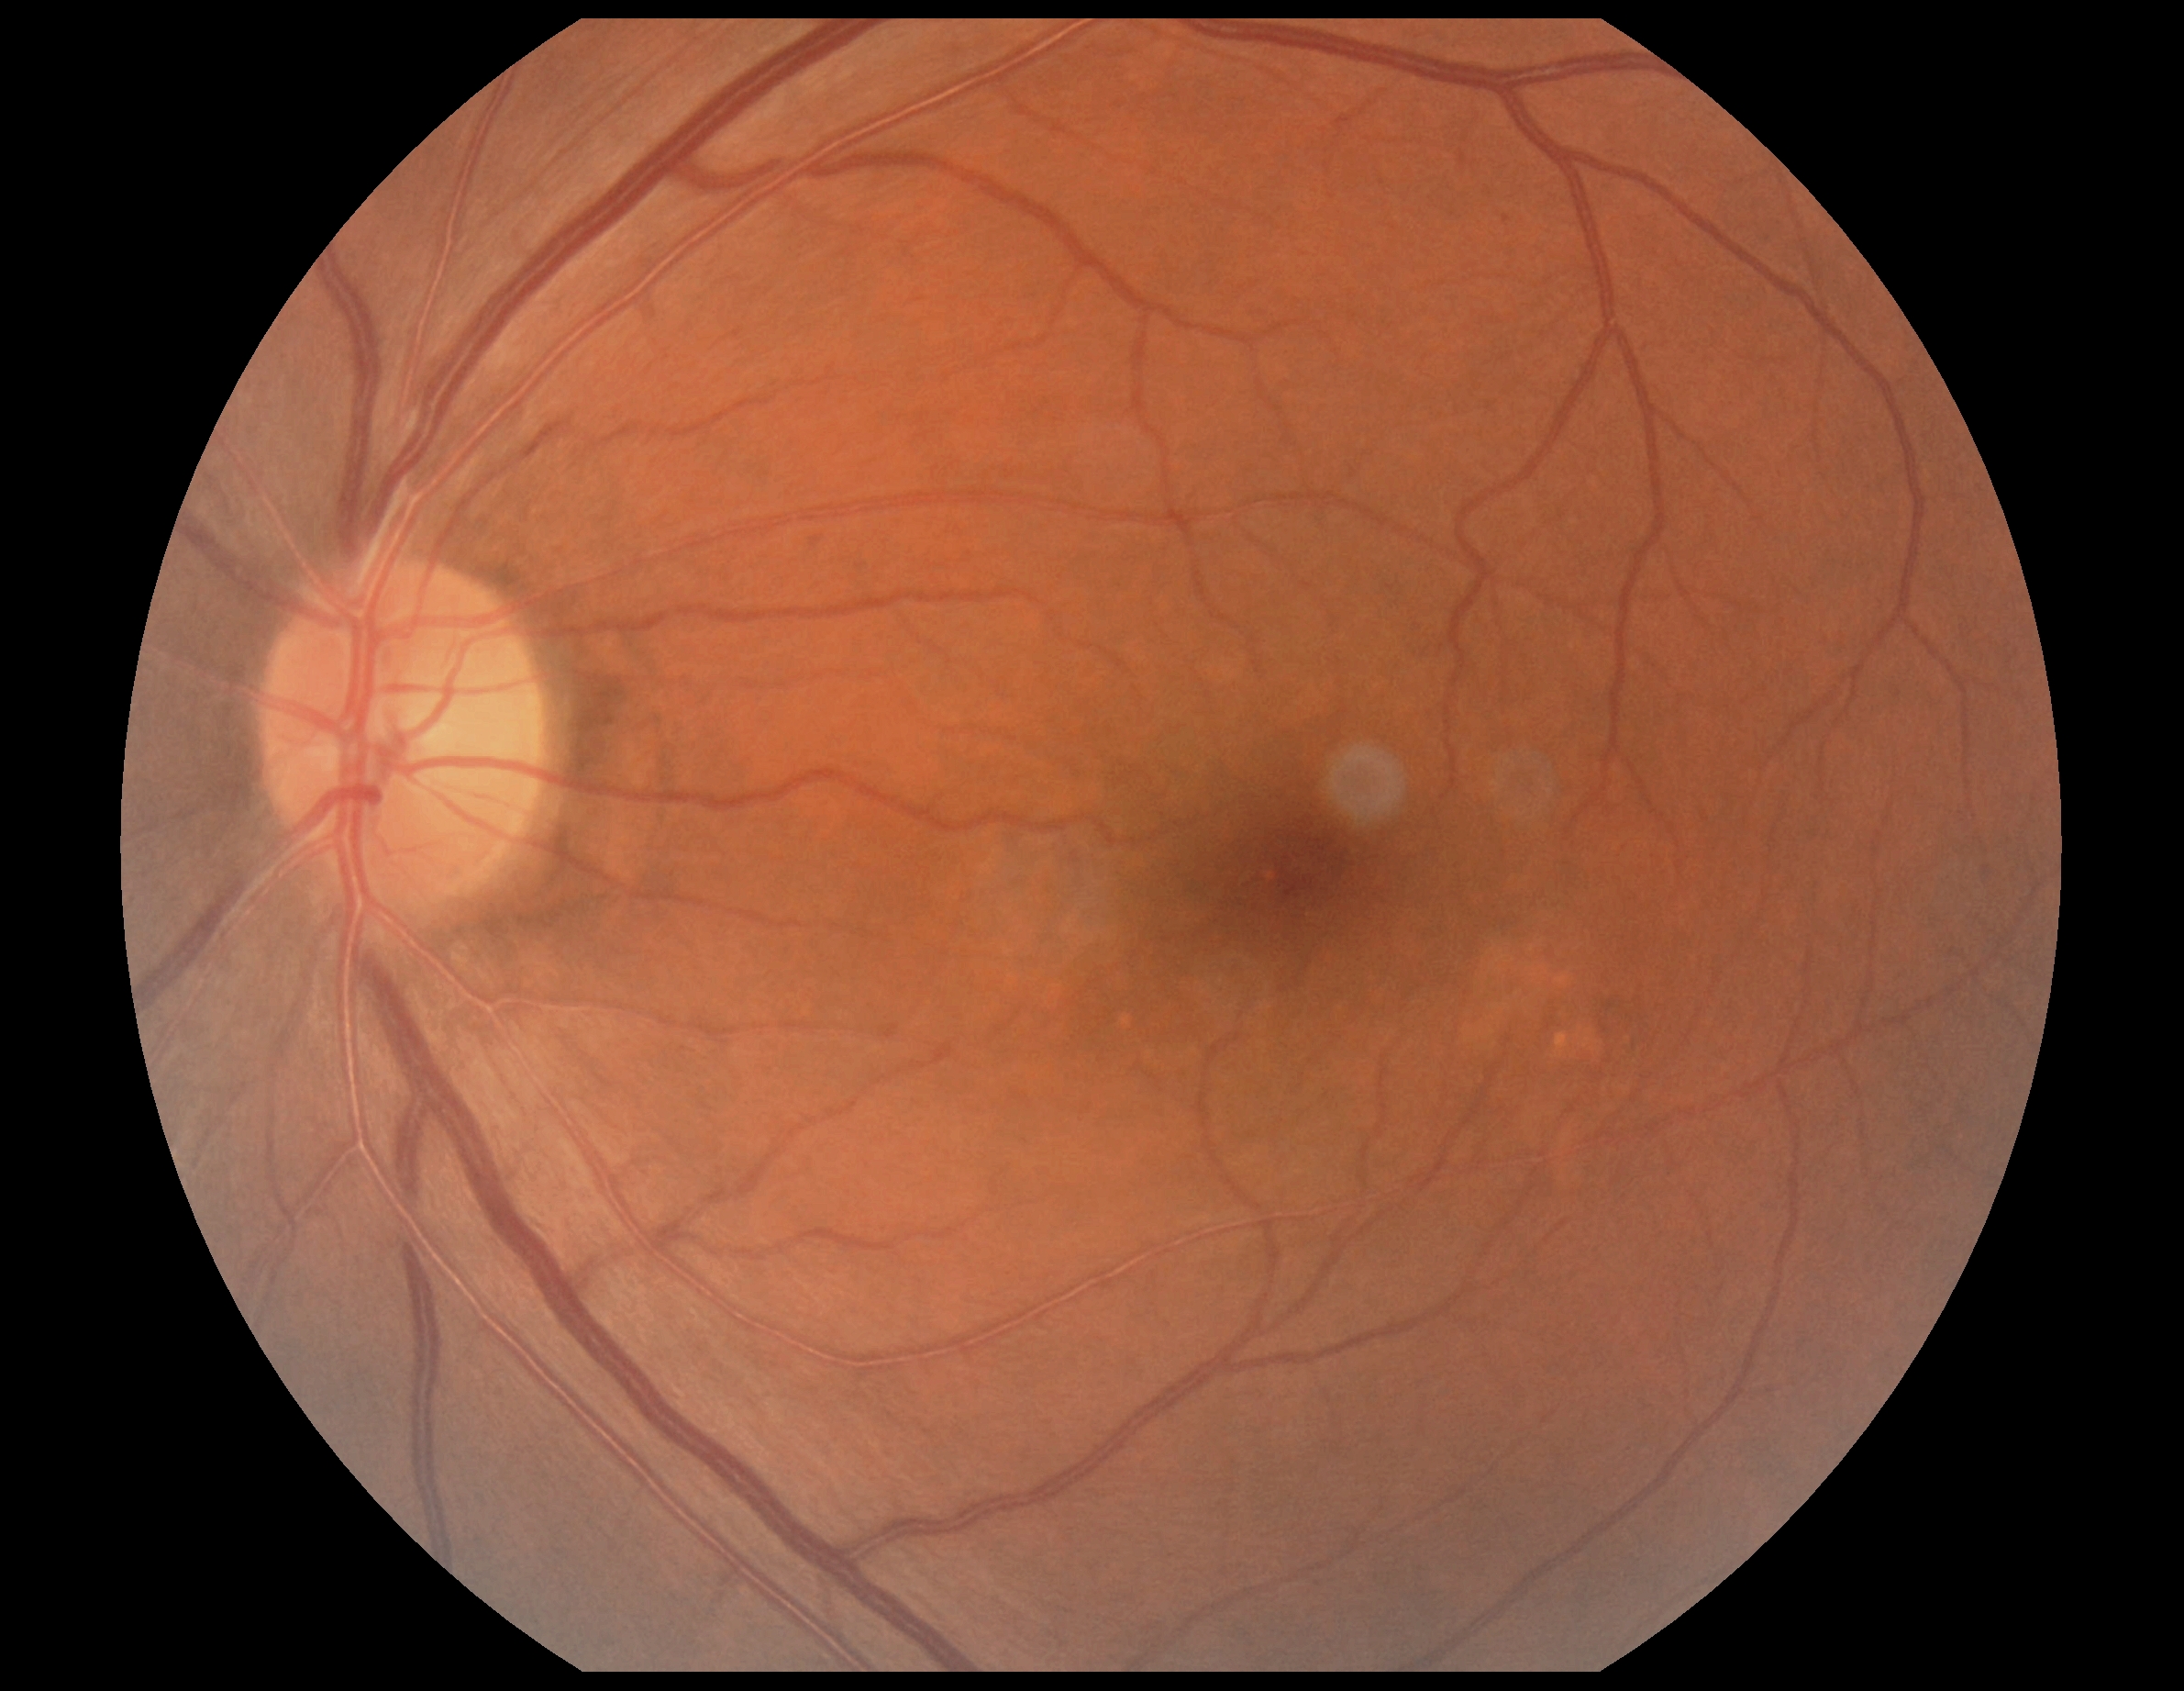
Diabetic retinopathy (DR) is grade 0 (no apparent retinopathy).